Macula-centered, camera: Kowa VX-10α, mydriatic (tropicamide 0.5%), 2361 x 1568 pixels: 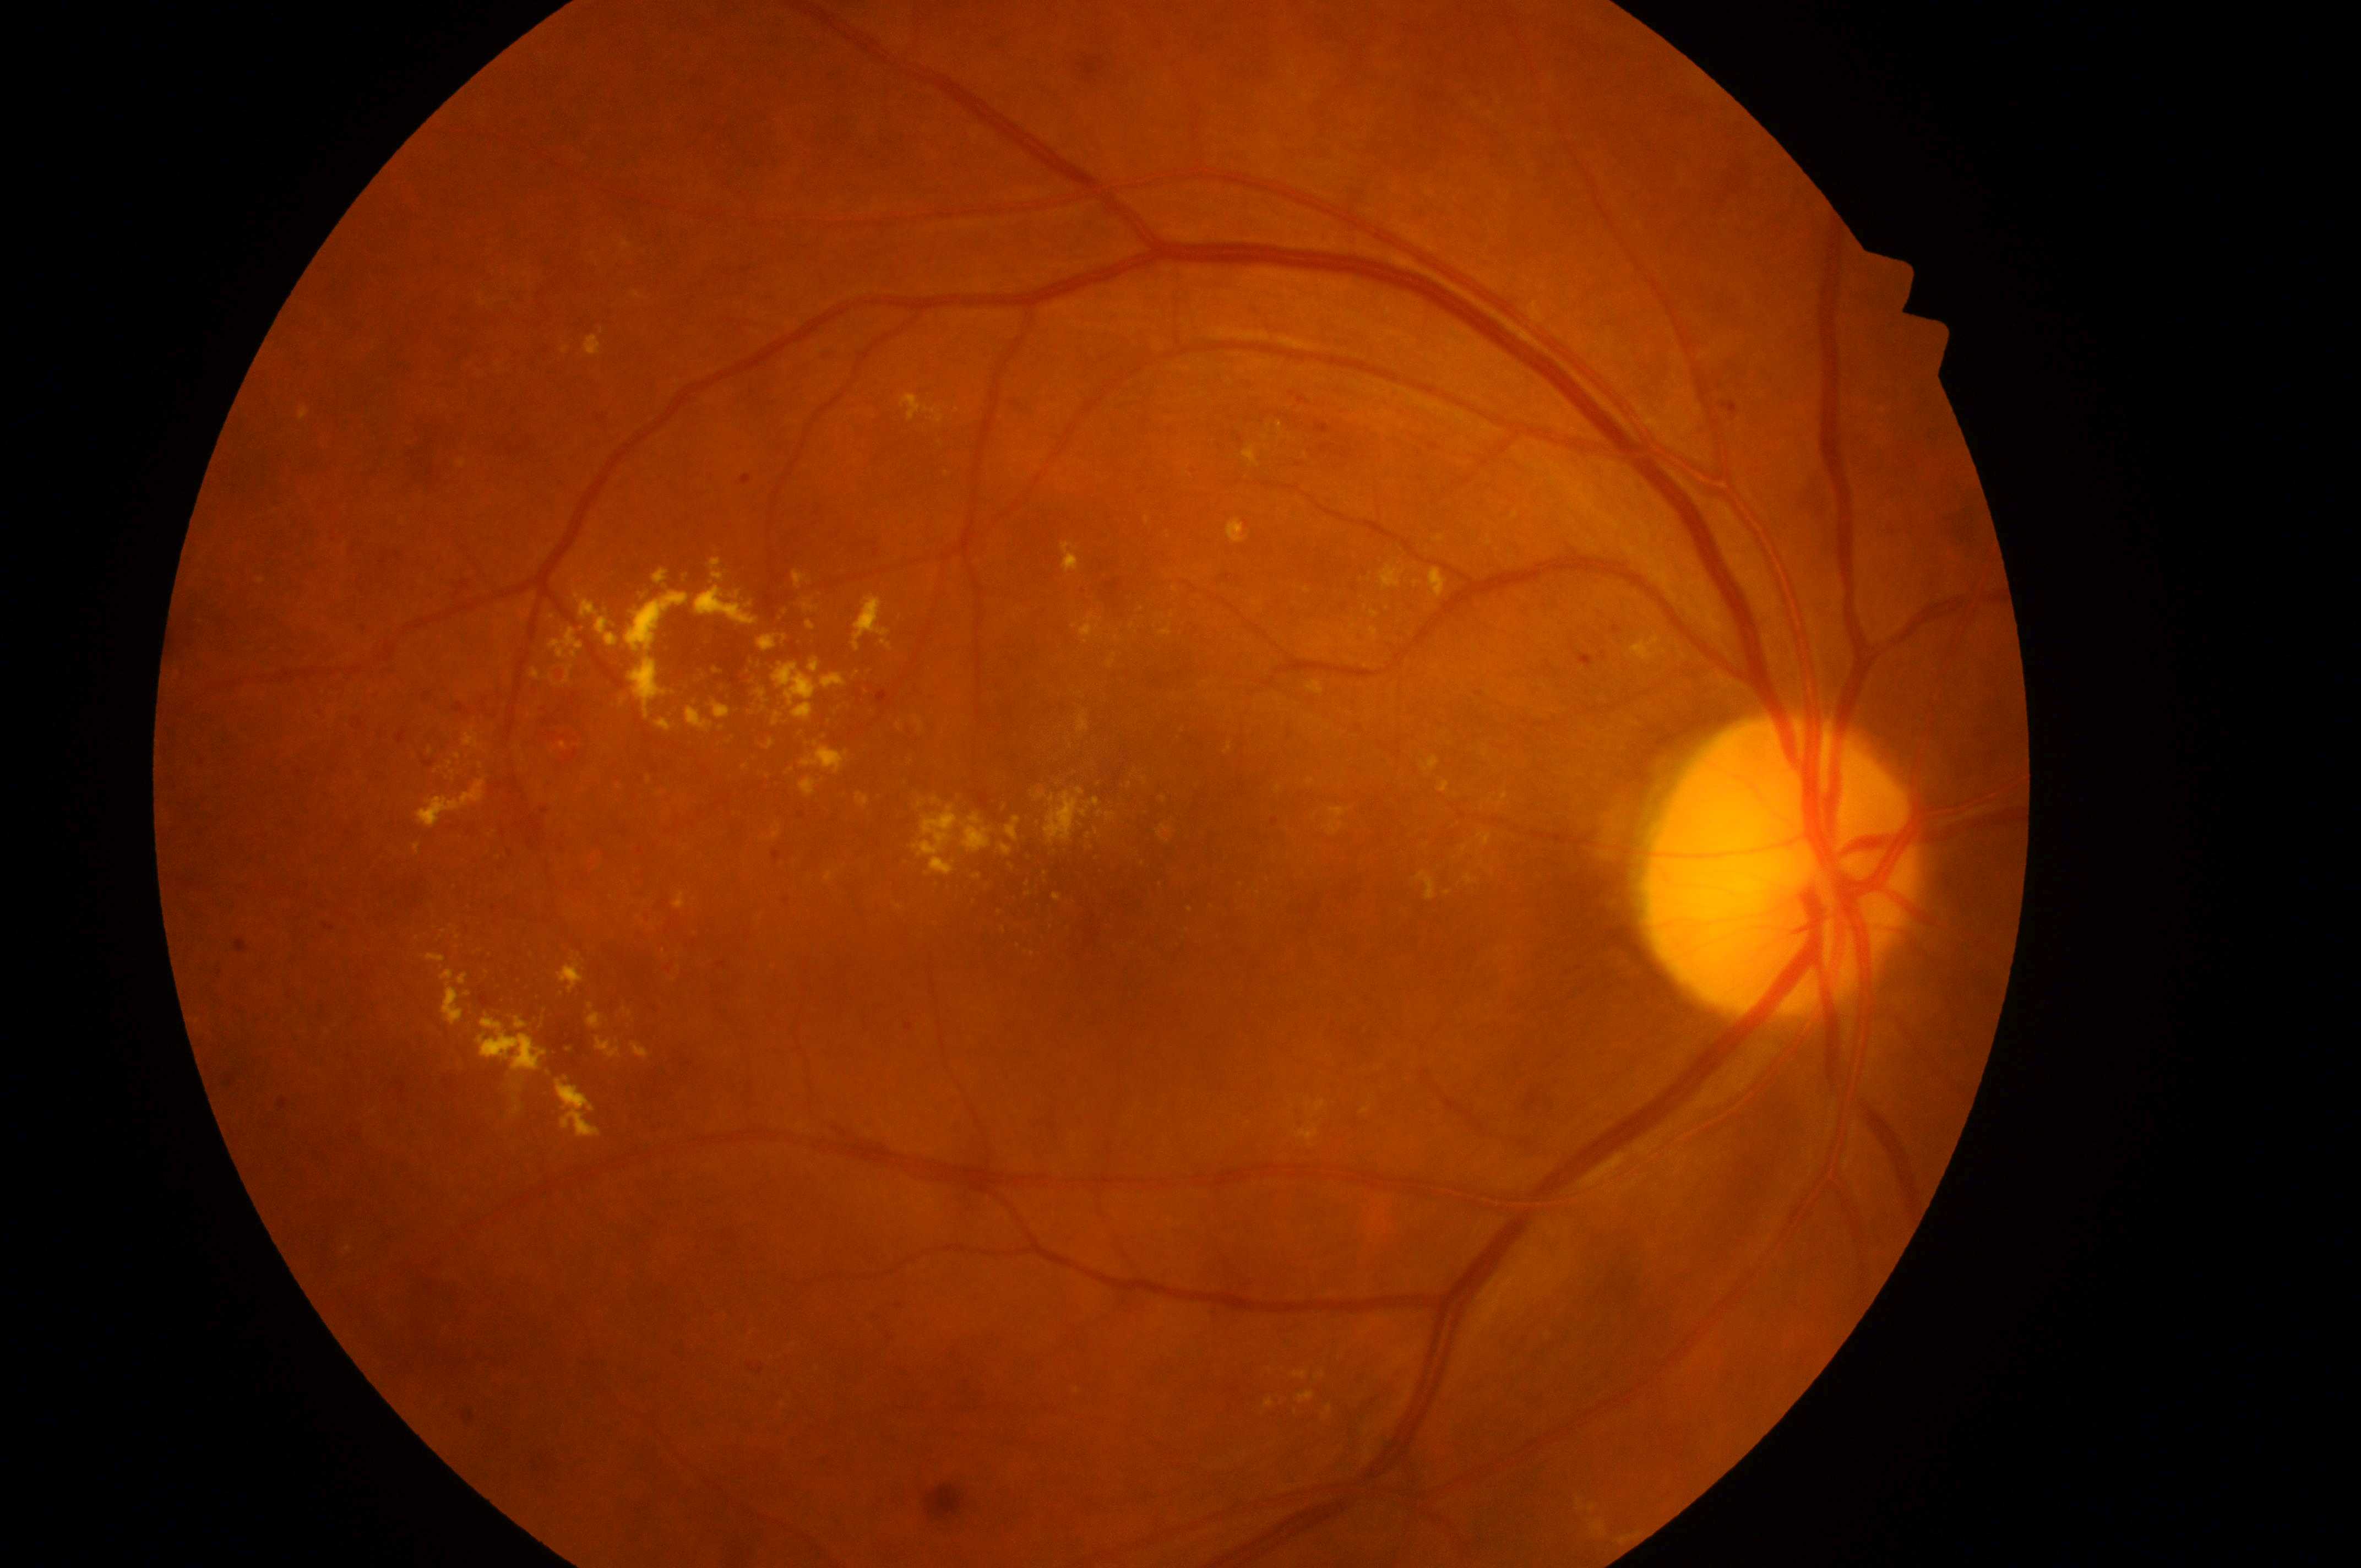
Retinopathy grade: 2 — more than just microaneurysms but less than severe NPDR.
Optic nerve head located at (1785,876).
The macular center is at (1107,919).
Diabetic macular edema: 2/2 — hard exudates within one disc diameter of the macula center.
The image shows the right eye.